Captured on a Nidek AFC-330 fundus camera · non-mydriatic fundus camera.
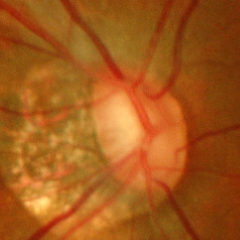
Glaucoma diagnosis = advanced-stage glaucoma.